Image size 2212x1659, 45-degree field of view: 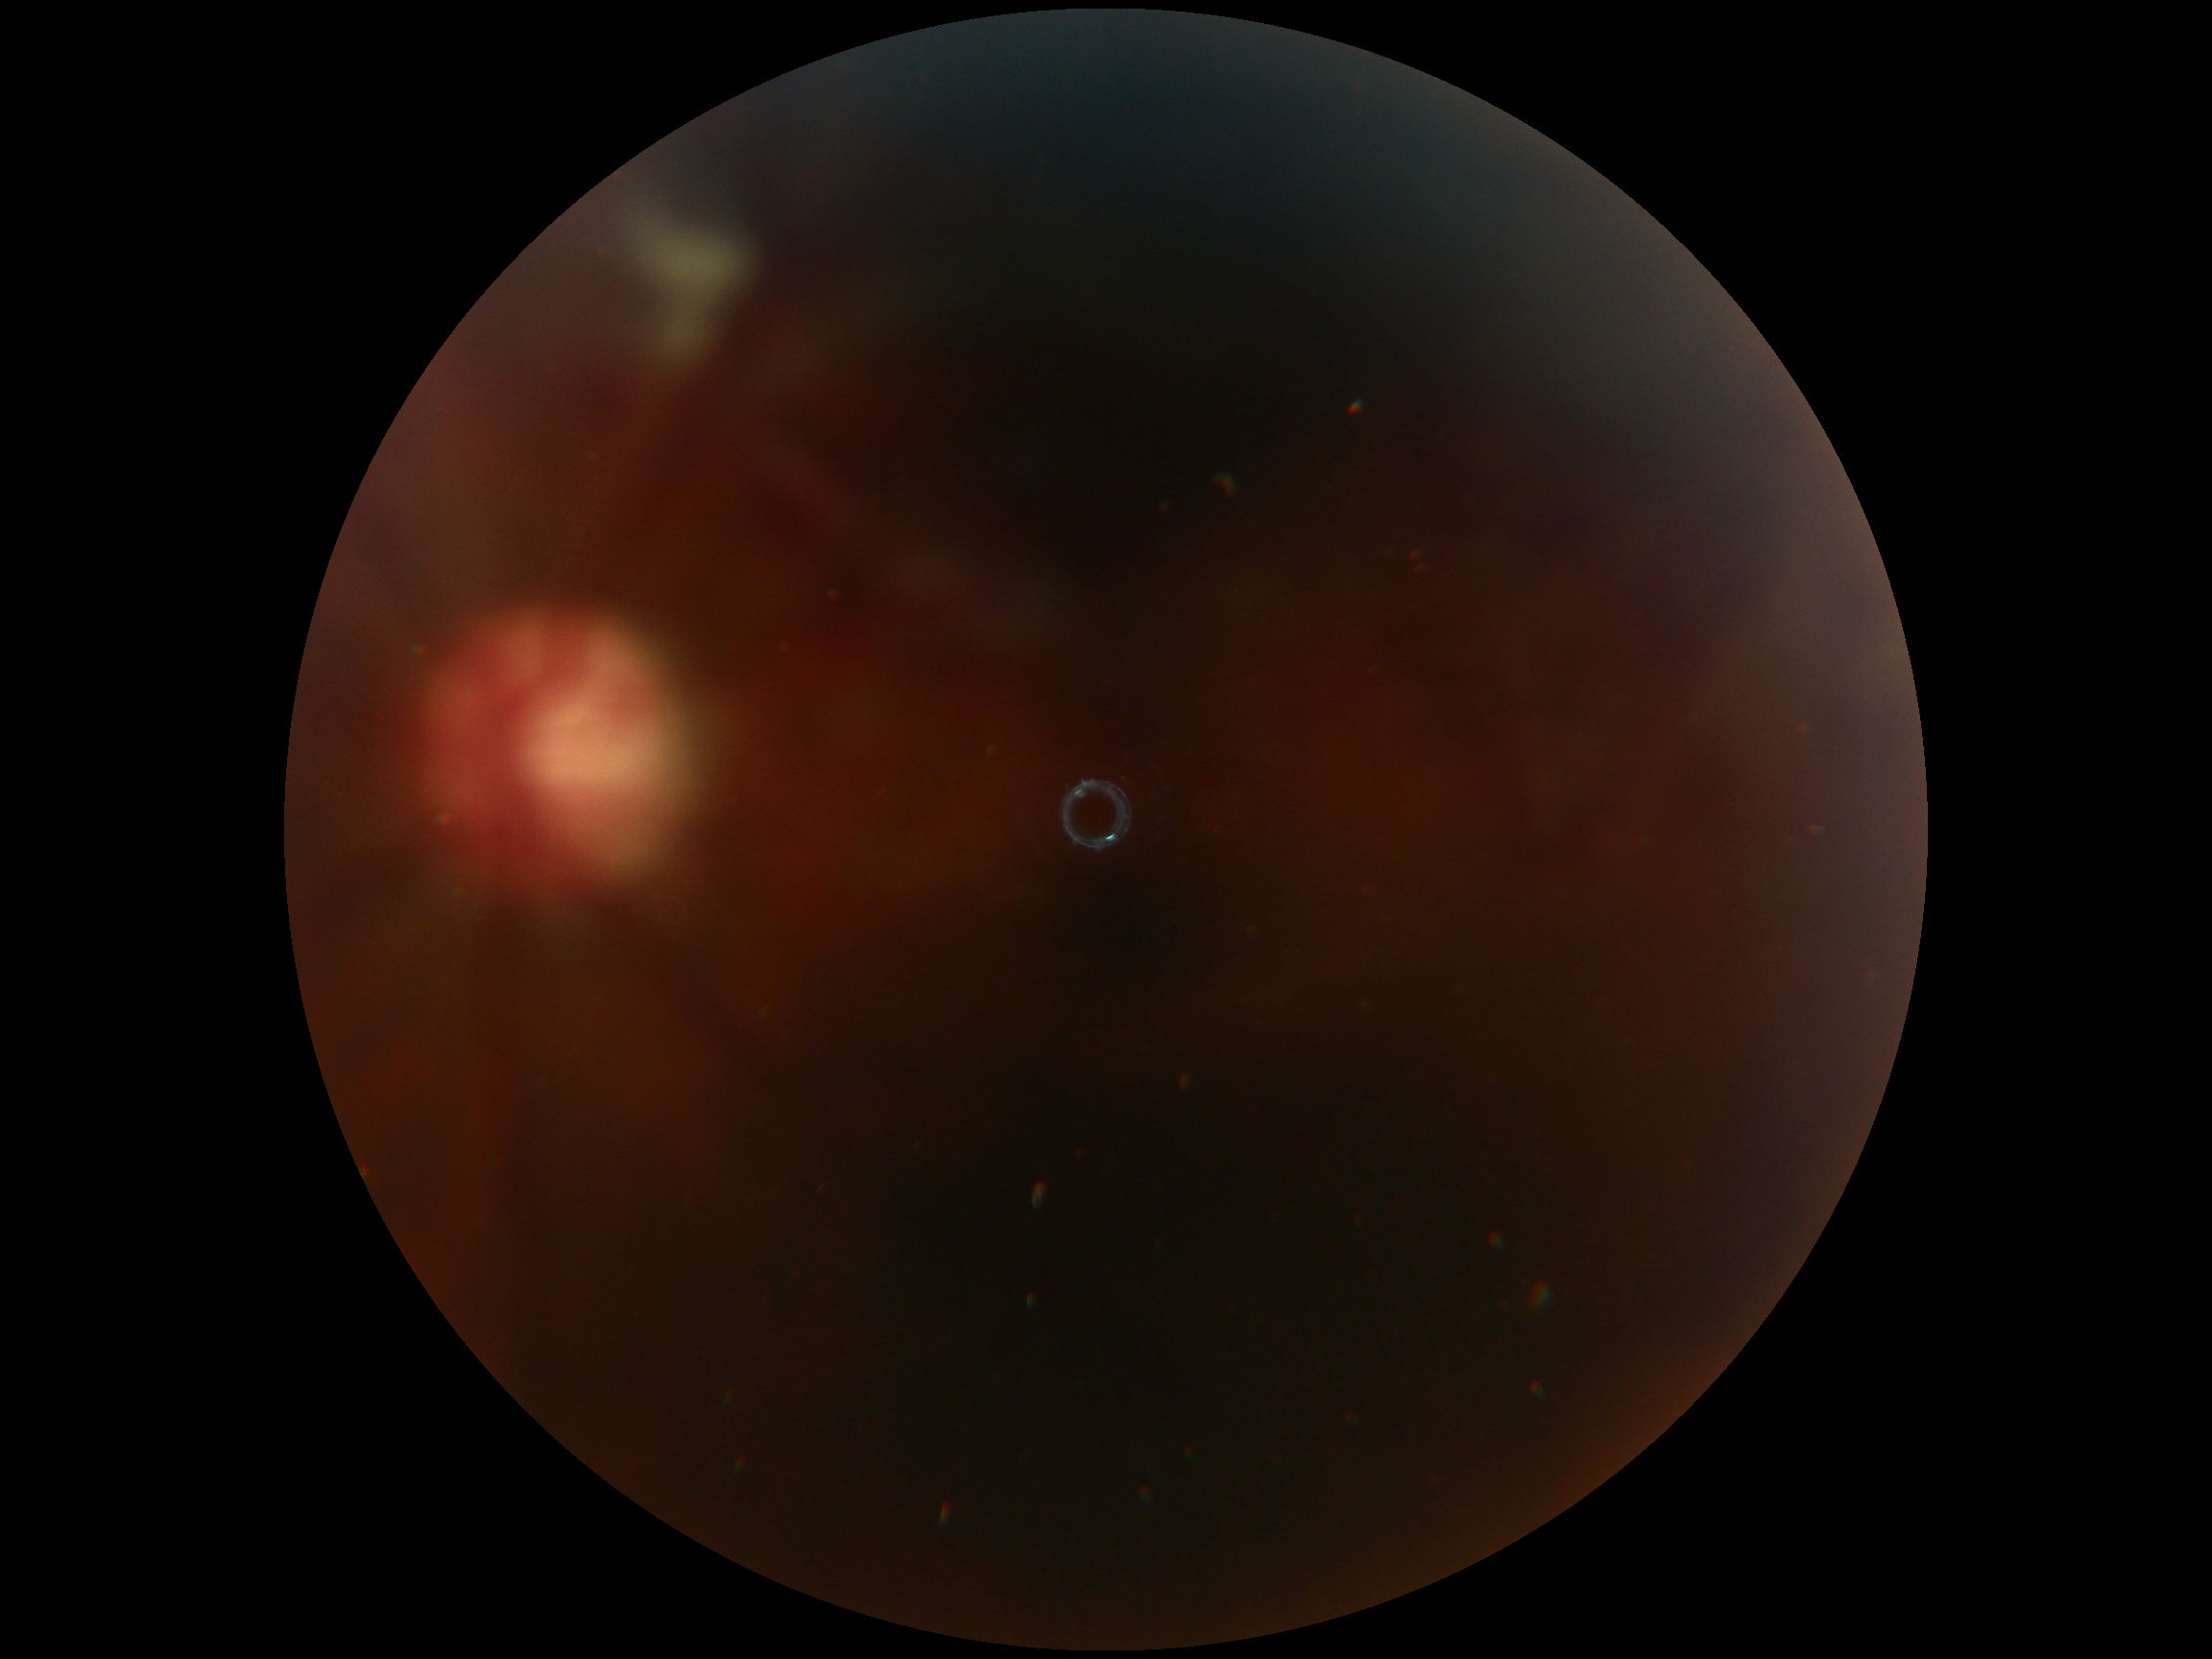

  dr_grade: ungradable